Posterior pole color fundus photograph. NIDEK AFC-230. Graded on the modified Davis scale. Nonmydriatic — 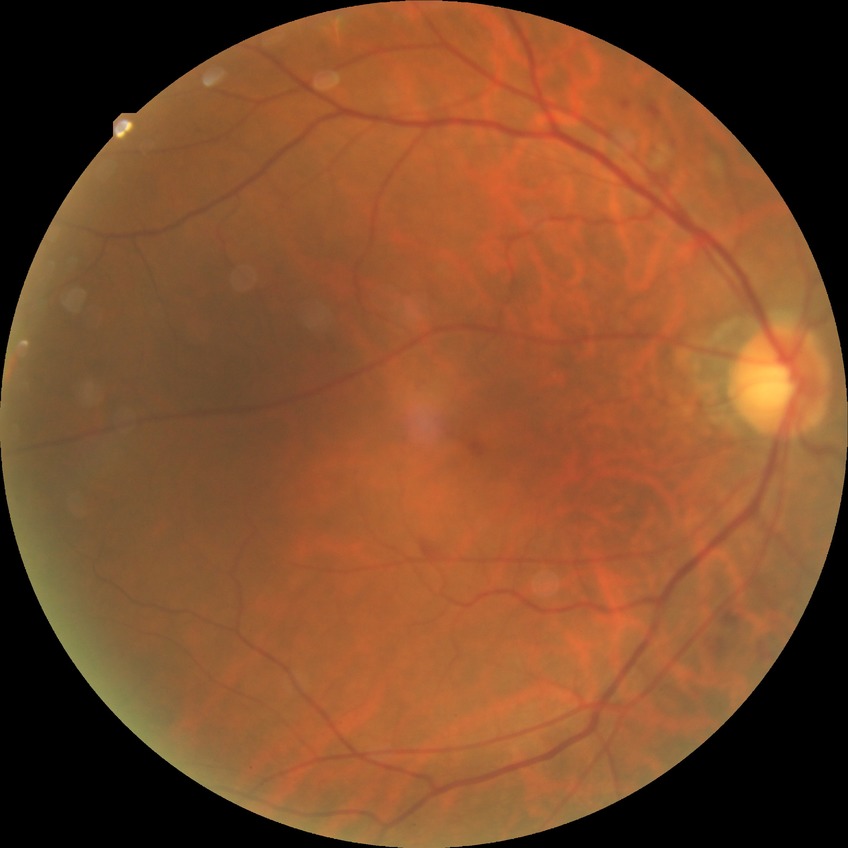

* diabetic retinopathy stage — simple diabetic retinopathy